Infant wide-field retinal image — 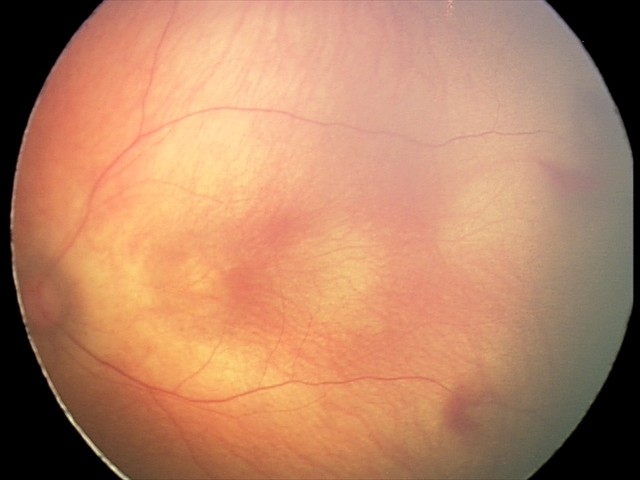
Diagnosis: retinal hemorrhages.